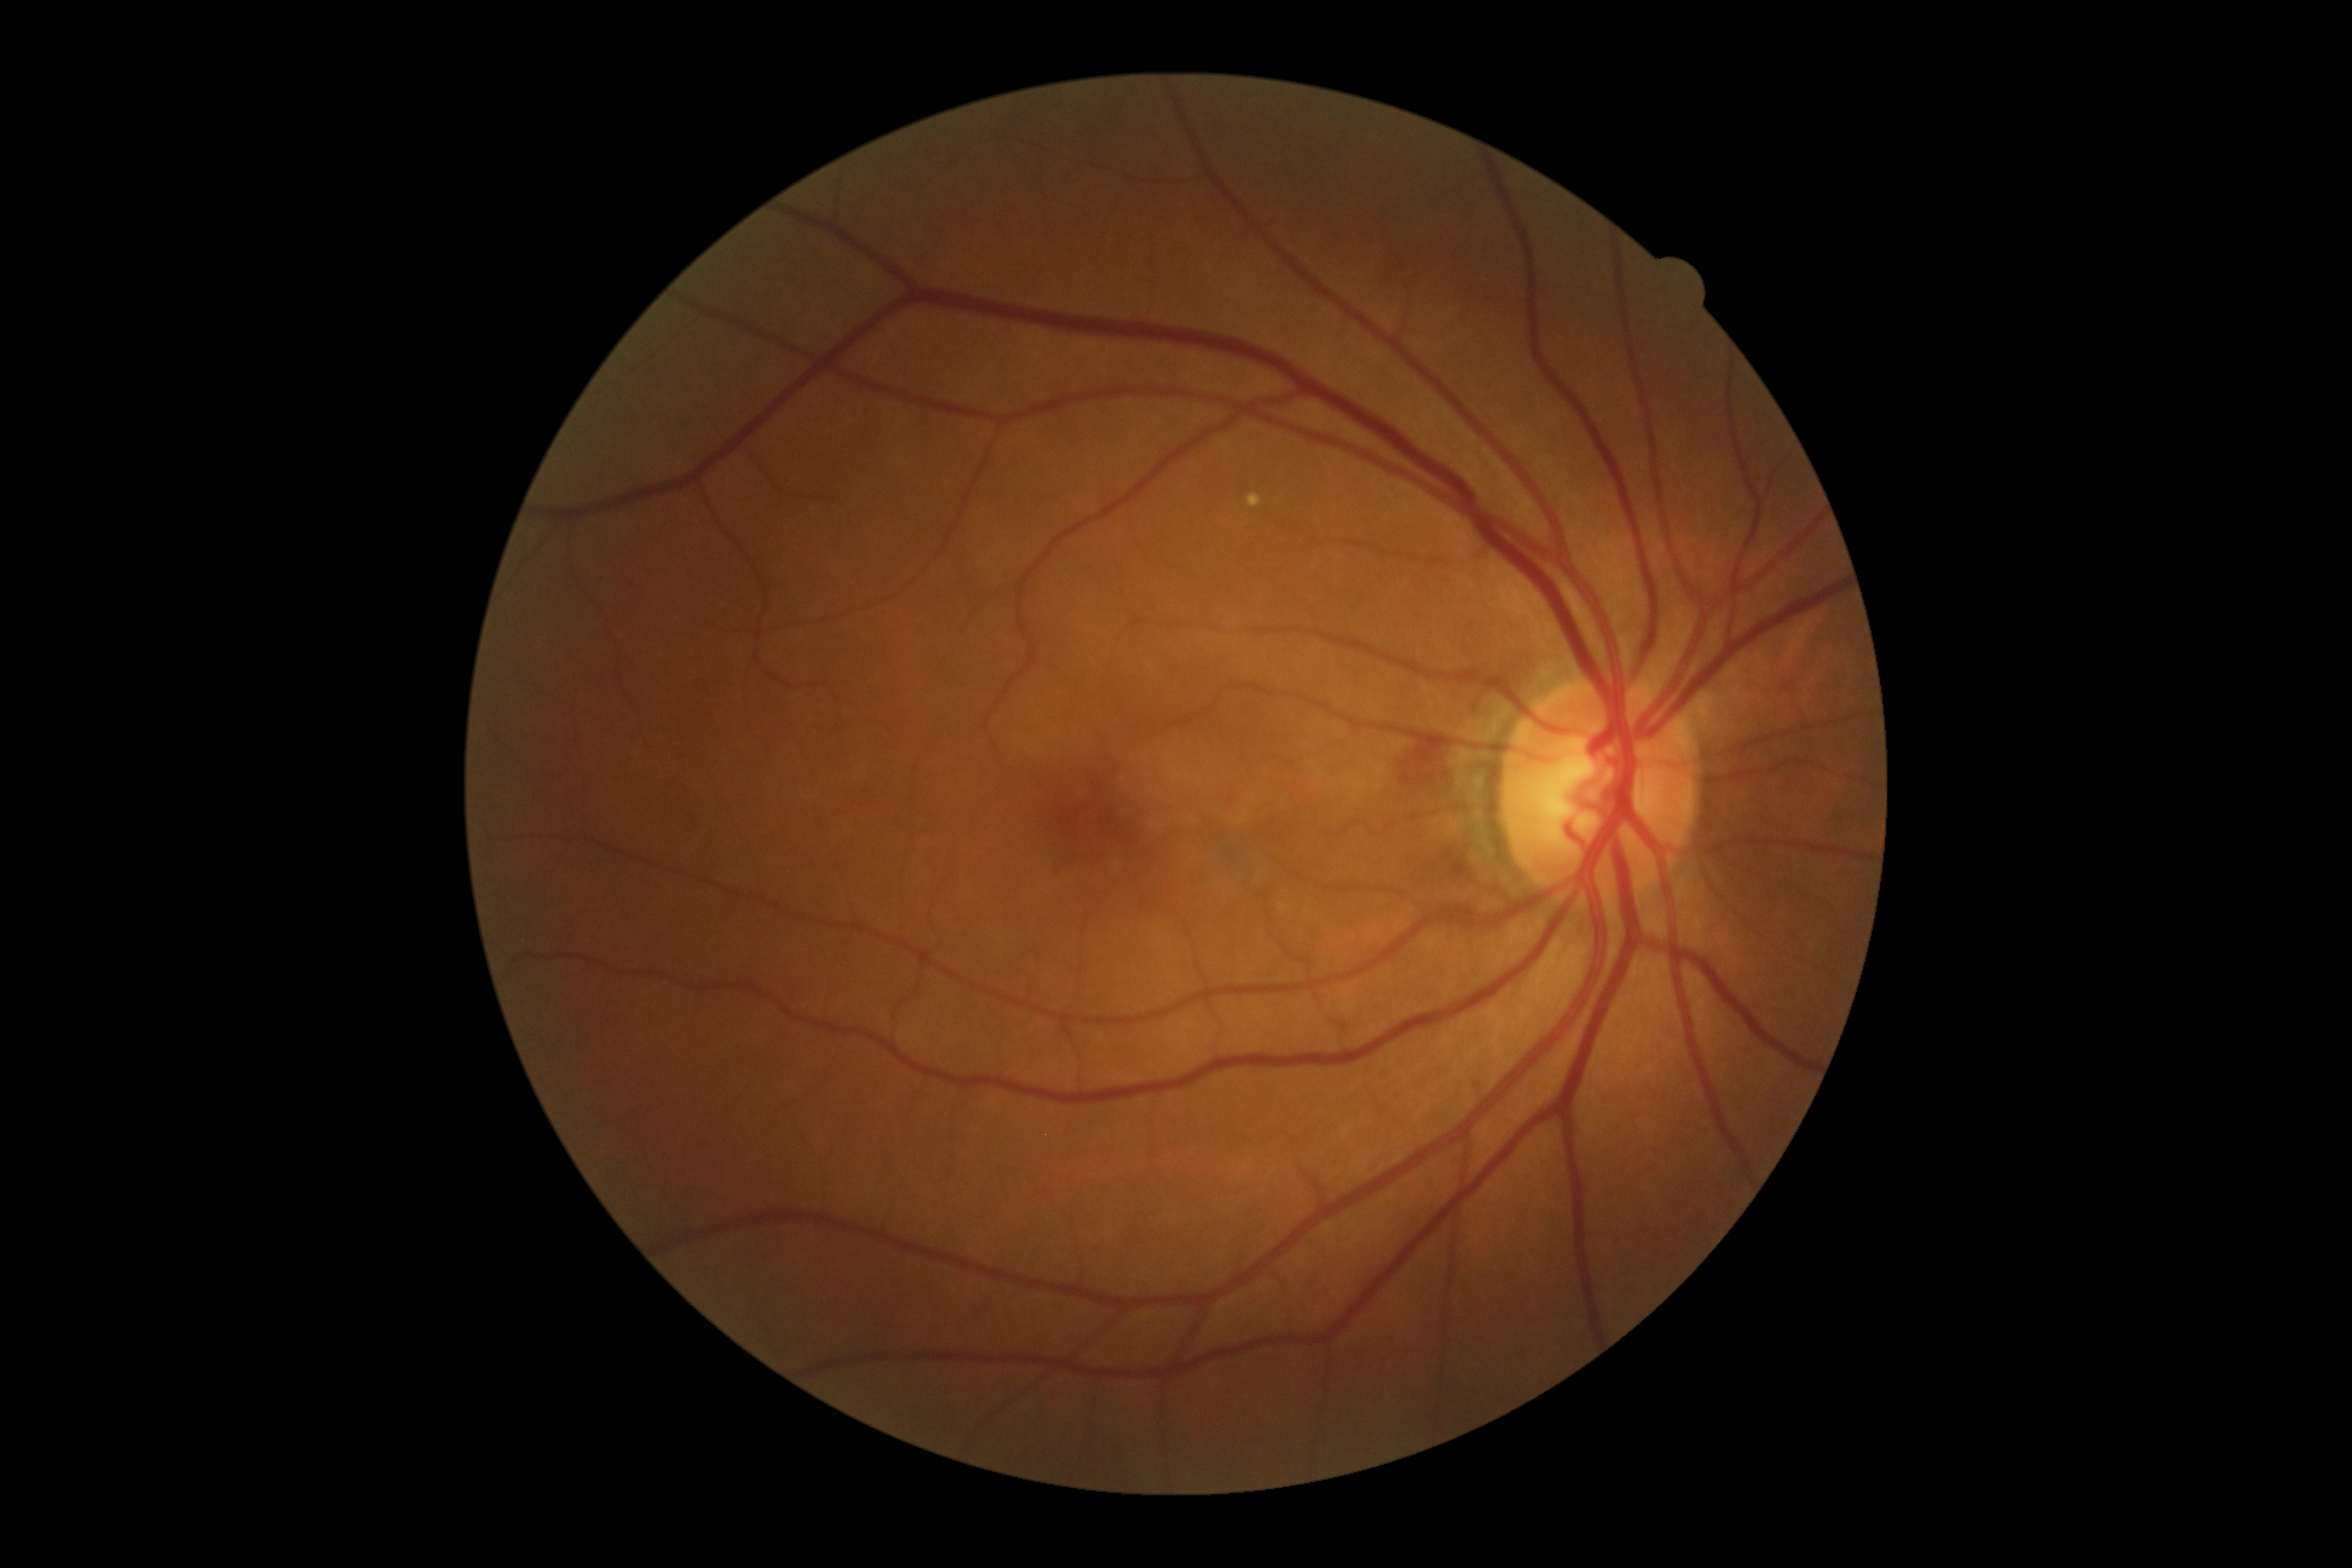
DR = 2/4; DR class = non-proliferative diabetic retinopathy.